Wide-field fundus photograph of an infant; 130° field of view (Natus RetCam Envision).
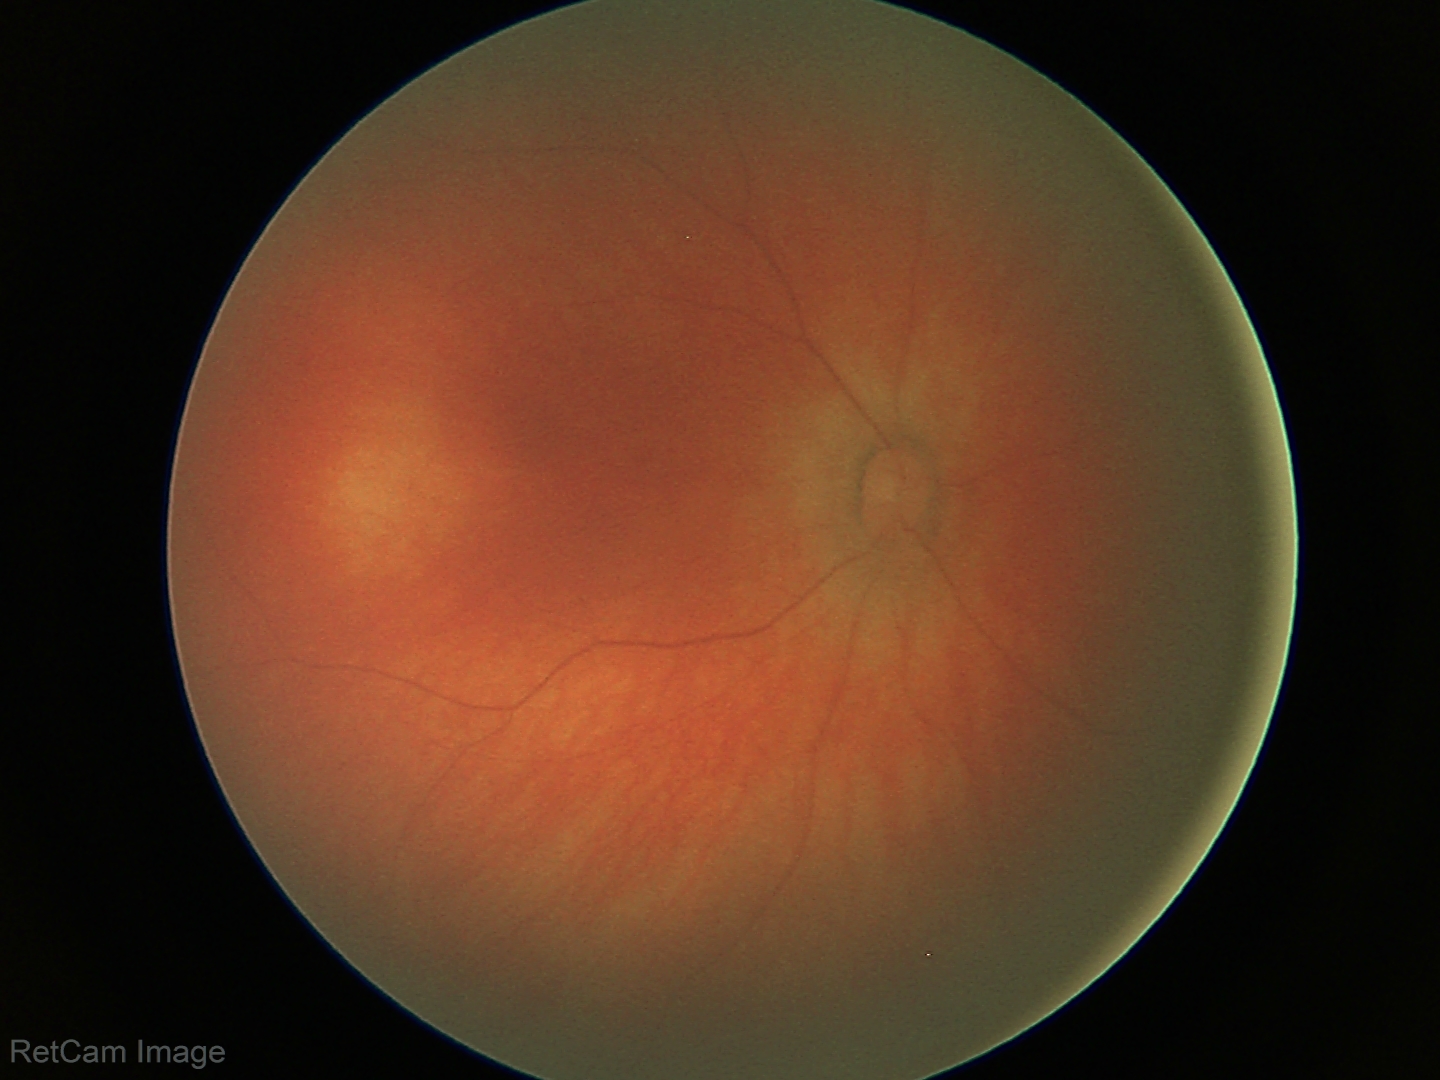

No retinal pathology identified on screening.